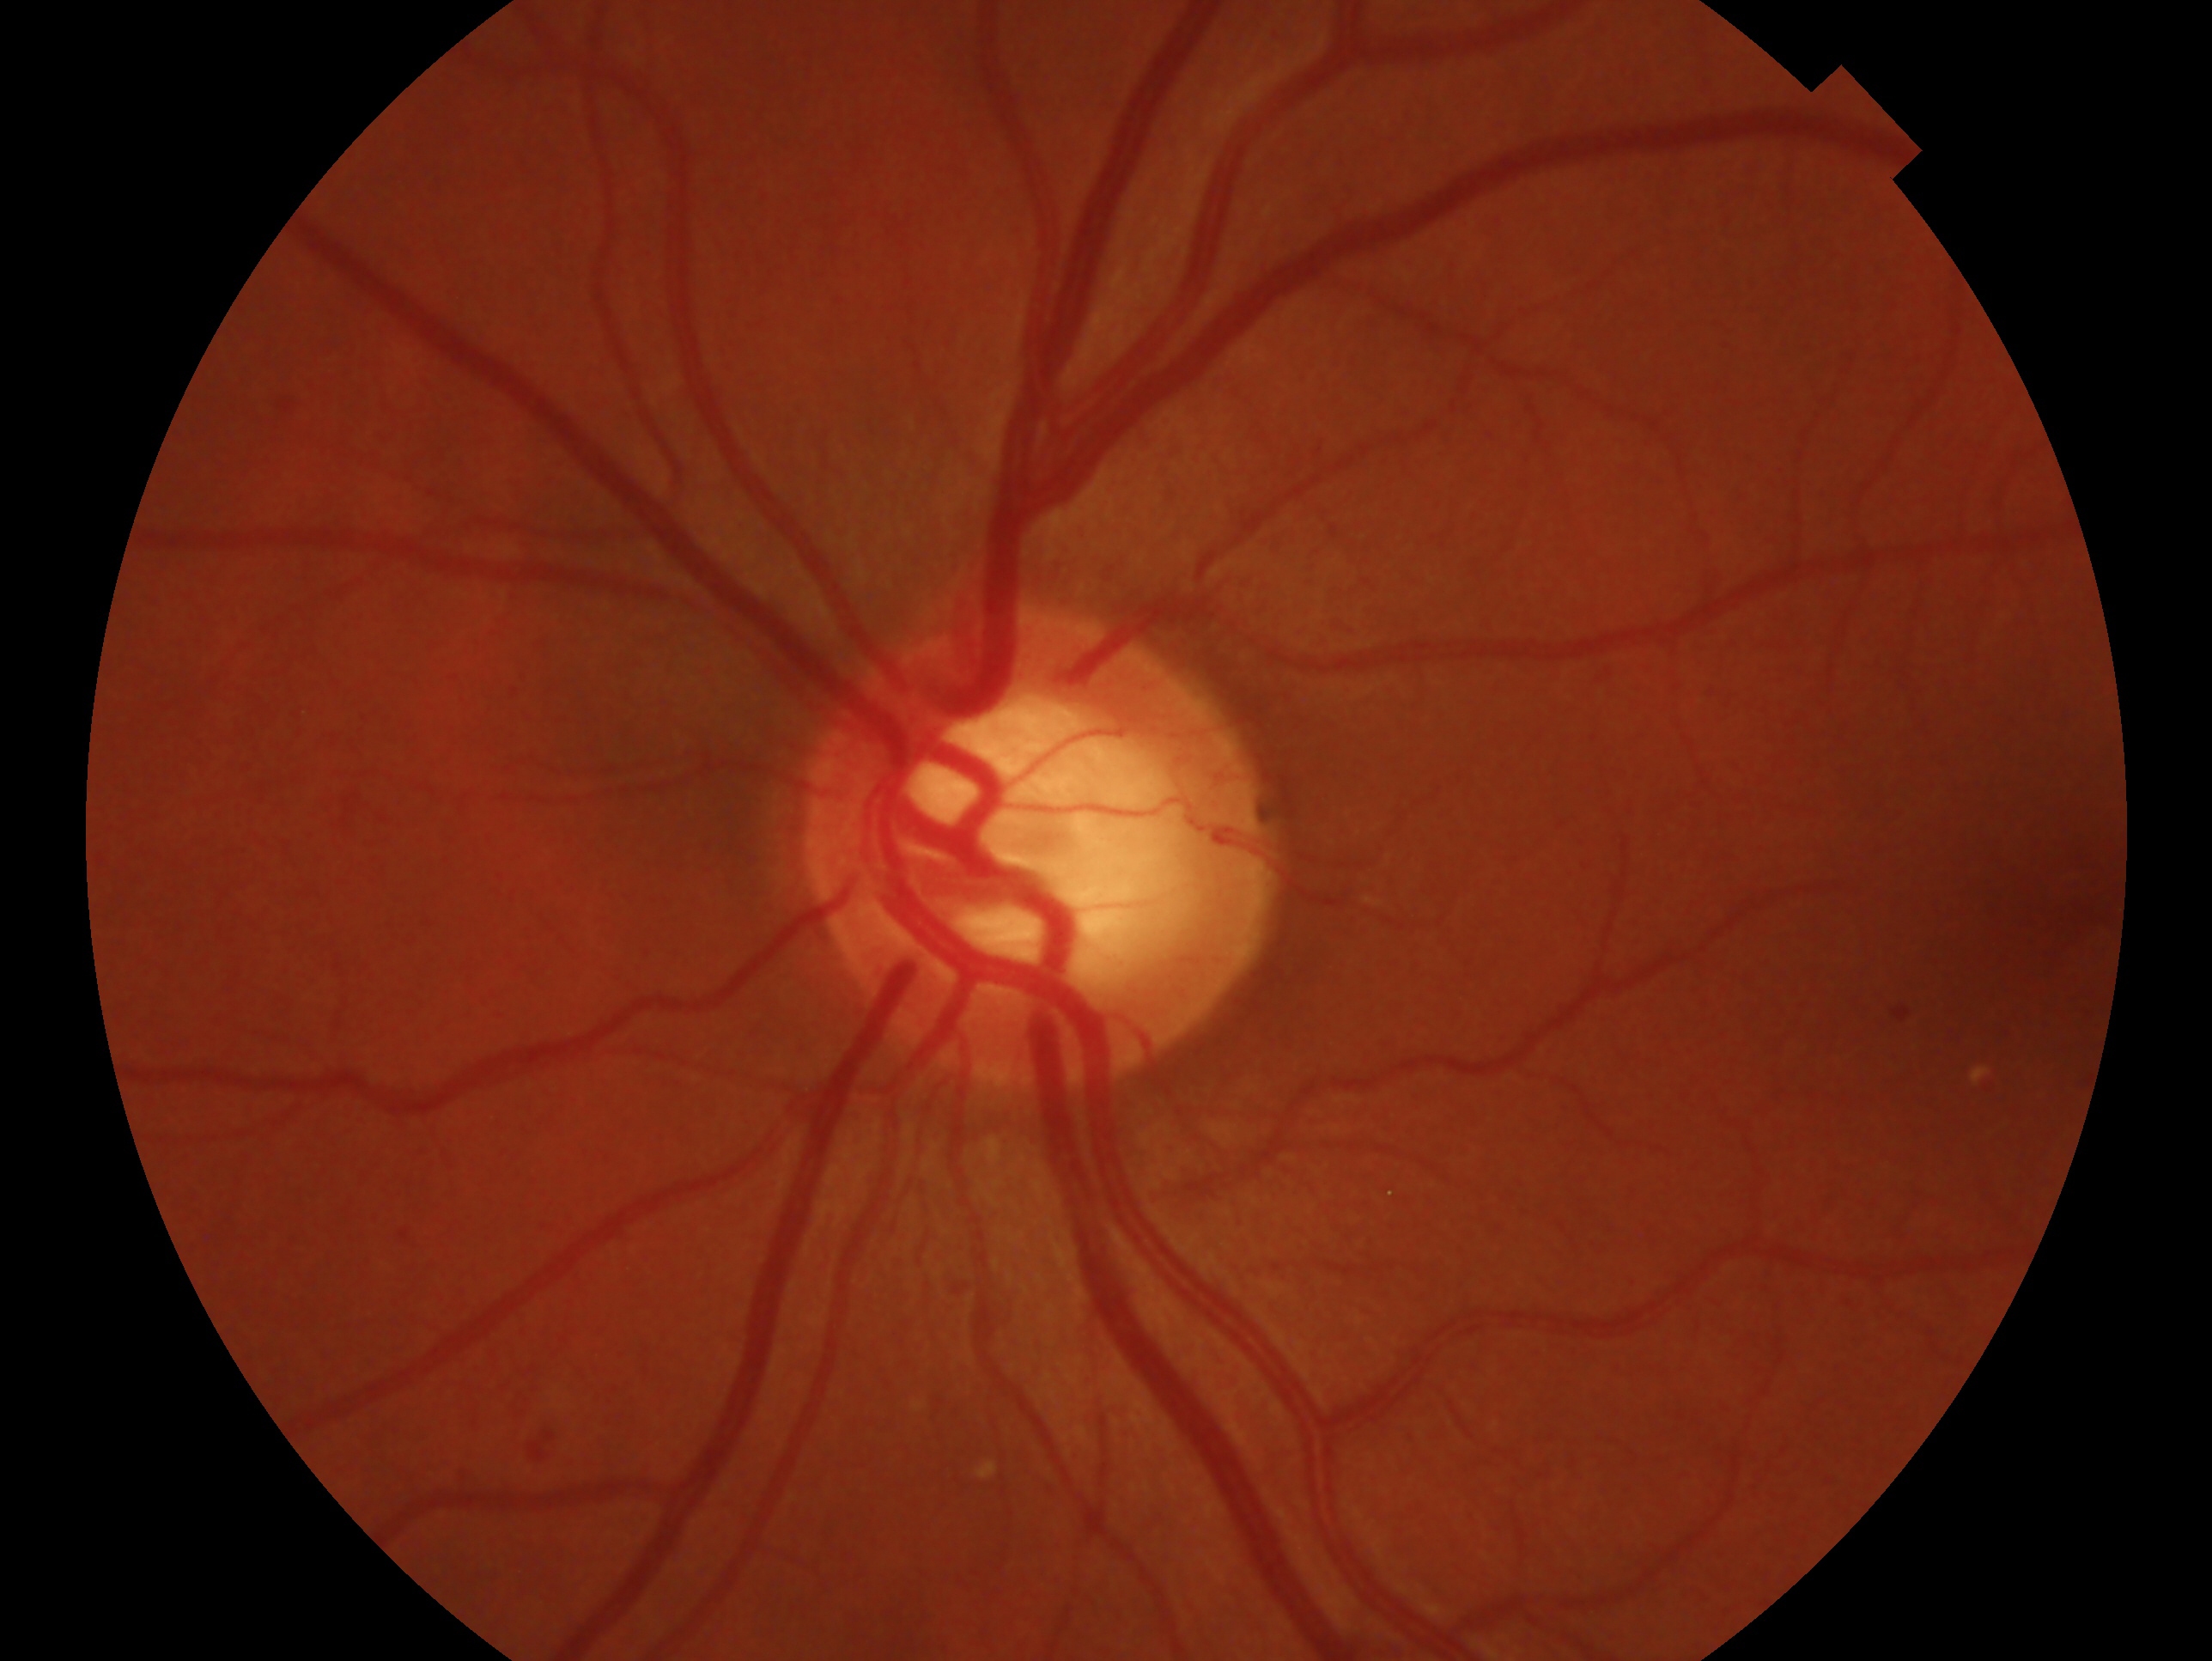
laterality: left
glaucoma assessment: suspect